2352 x 1568 pixels · CFP · FOV: 45 degrees
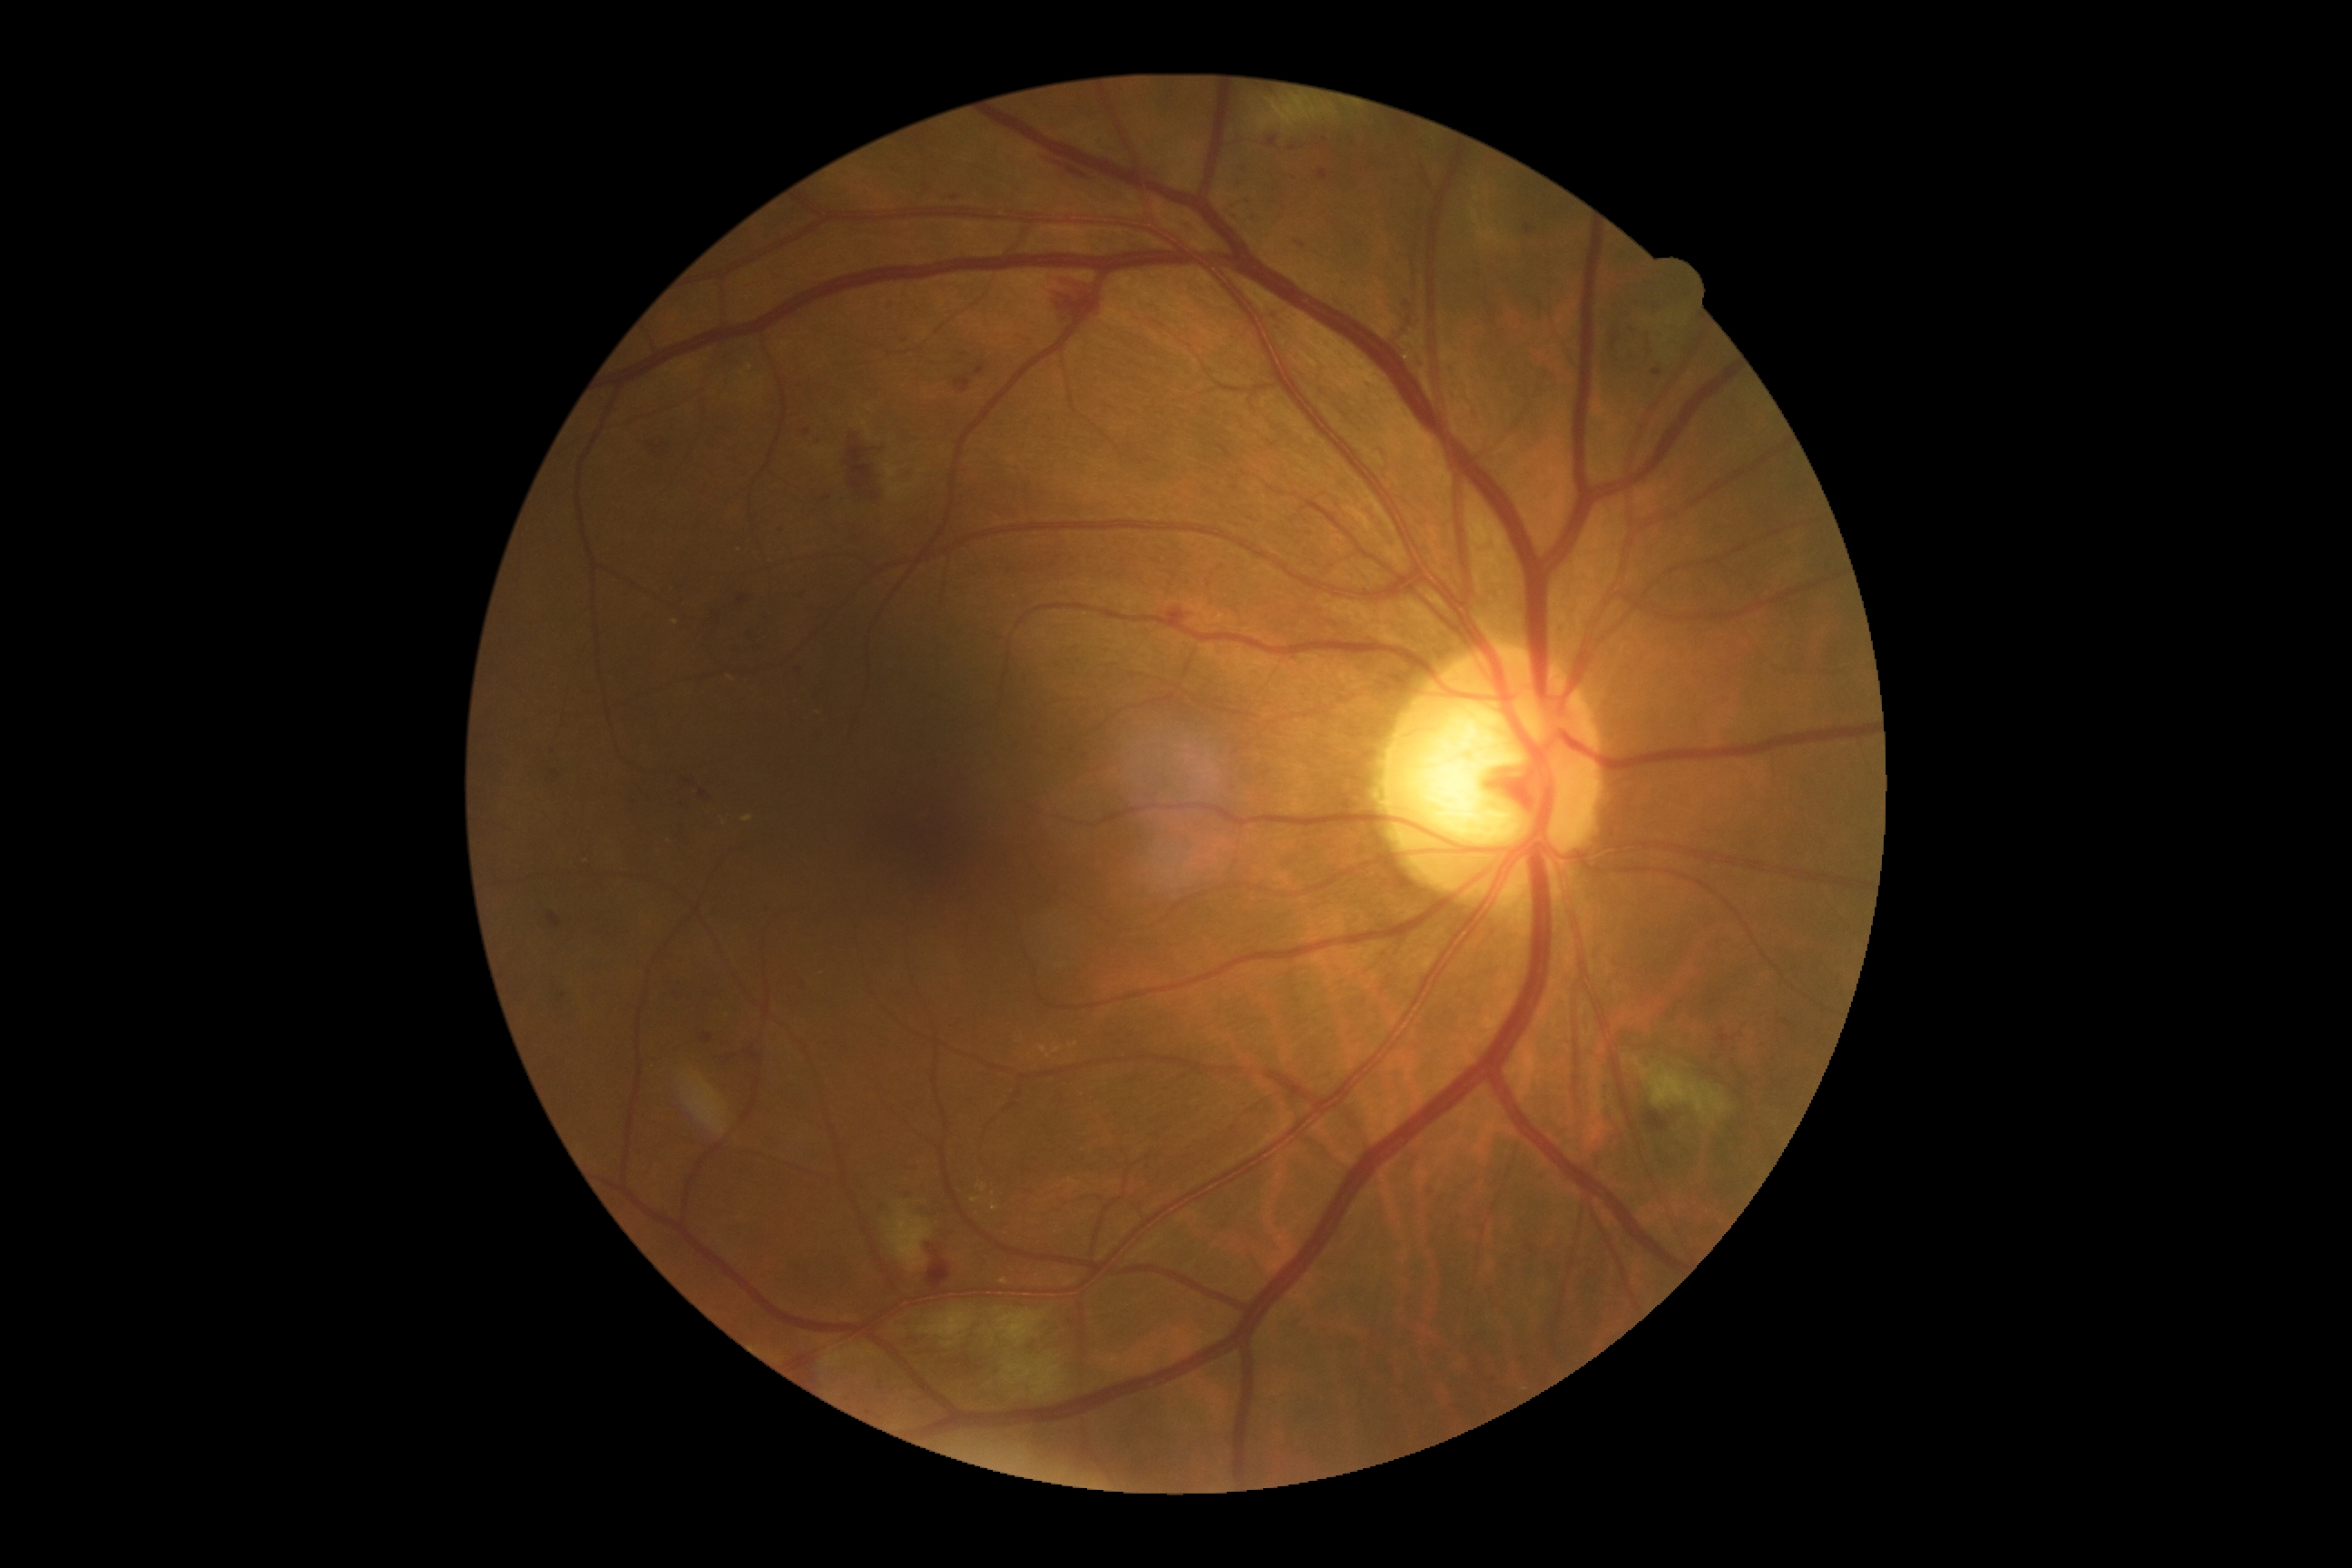

DR=grade 2 (moderate NPDR).